Davis DR grading
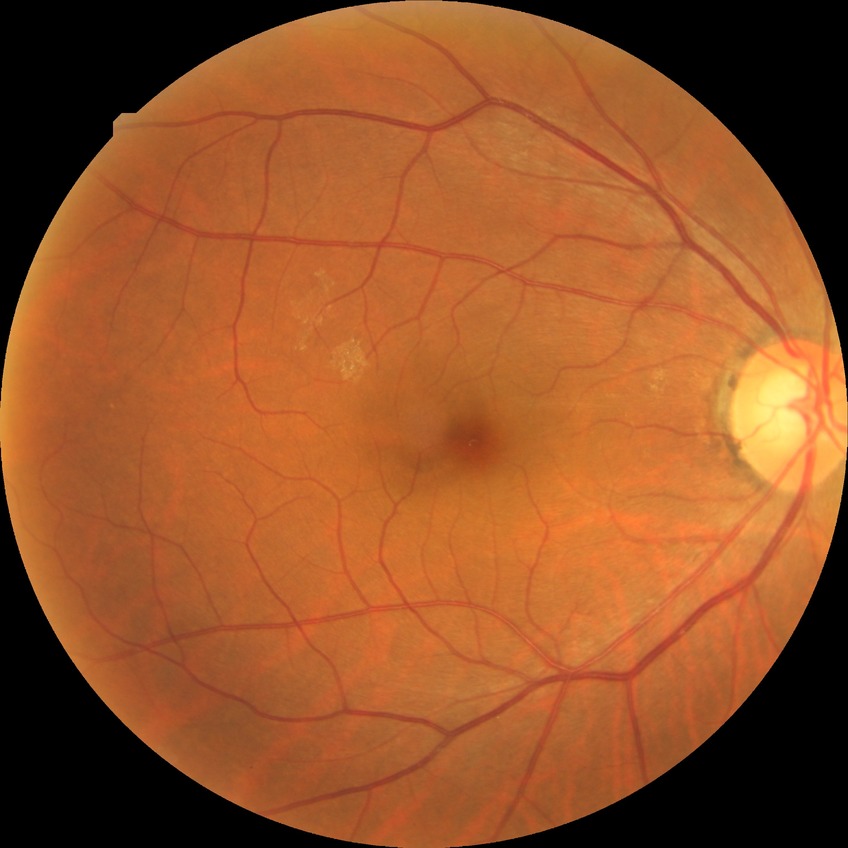 {
  "davis_grade": "no diabetic retinopathy"
}